FOV: 45 degrees: 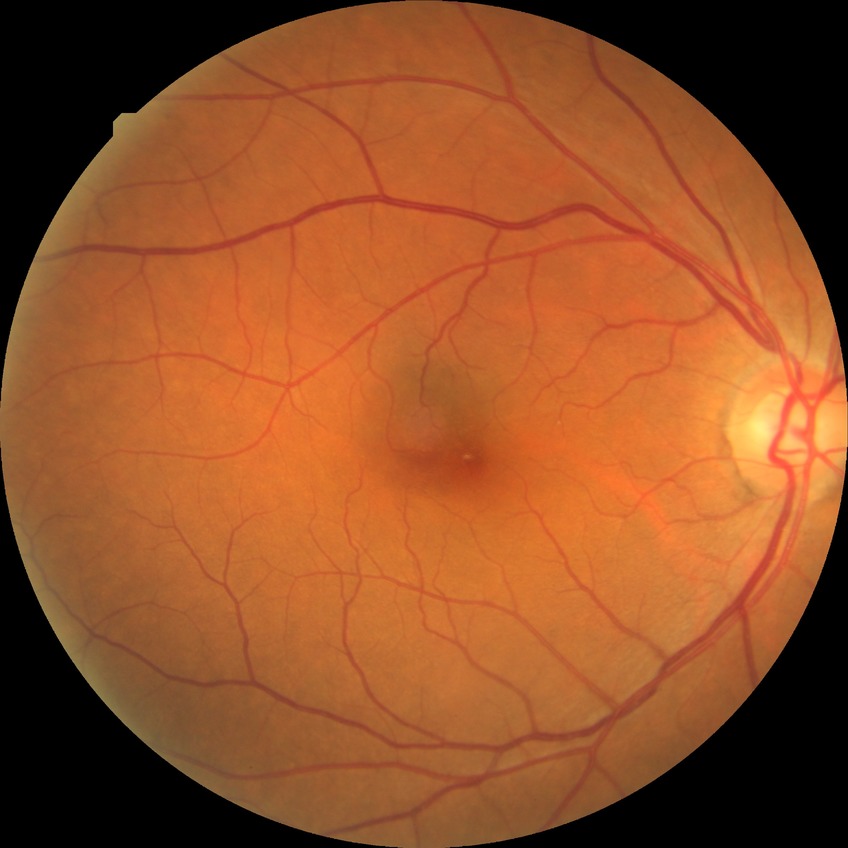
Modified Davis classification: no diabetic retinopathy.